Posterior pole color fundus photograph · NIDEK AFC-230 · 848 x 848 pixels · no pharmacologic dilation · 45 degree fundus photograph
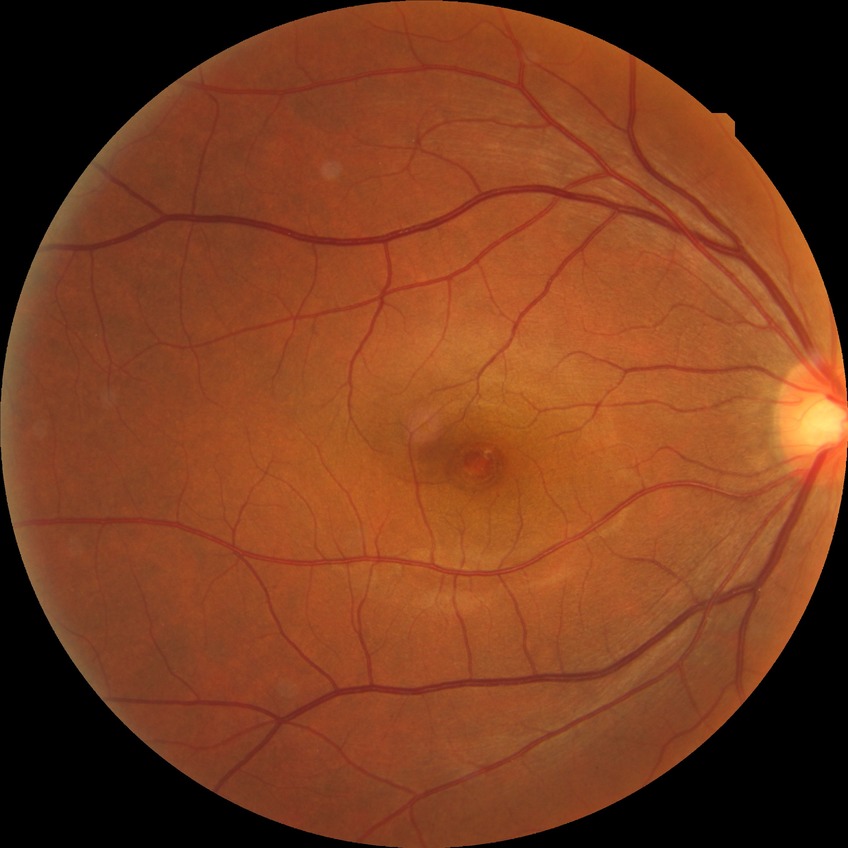 {"davis_grade": "no diabetic retinopathy"}